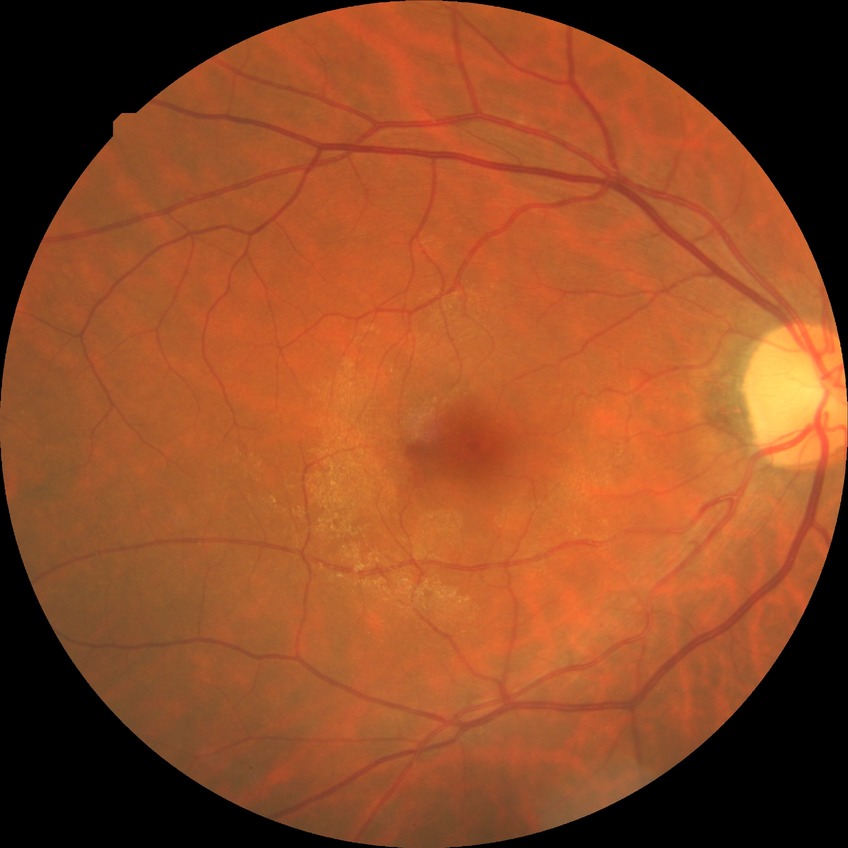 diabetic retinopathy (DR): NDR (no diabetic retinopathy).